Color fundus photograph — 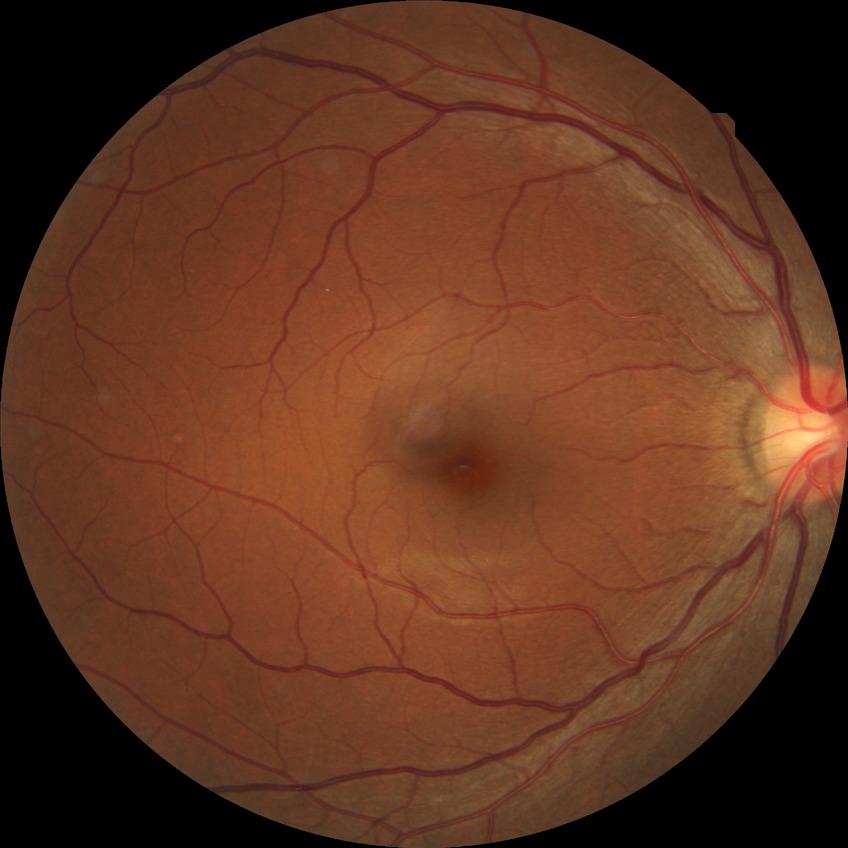
DR severity=NDR.